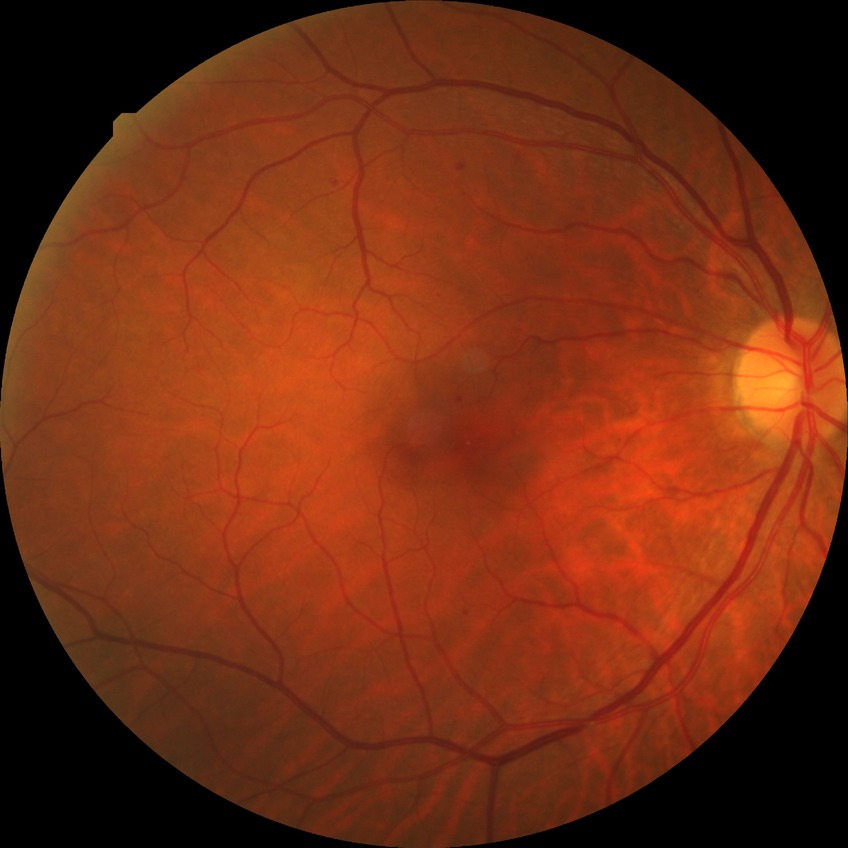
DR severity is SDR.